240x240px. Non-mydriatic acquisition. Centered on the optic disc: 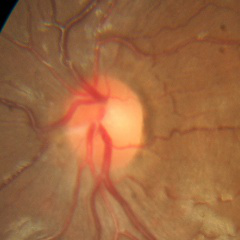 Optic disc appearance consistent with no evidence of glaucoma.